Image size 1924x1556. Ultra-widefield fundus mosaic — 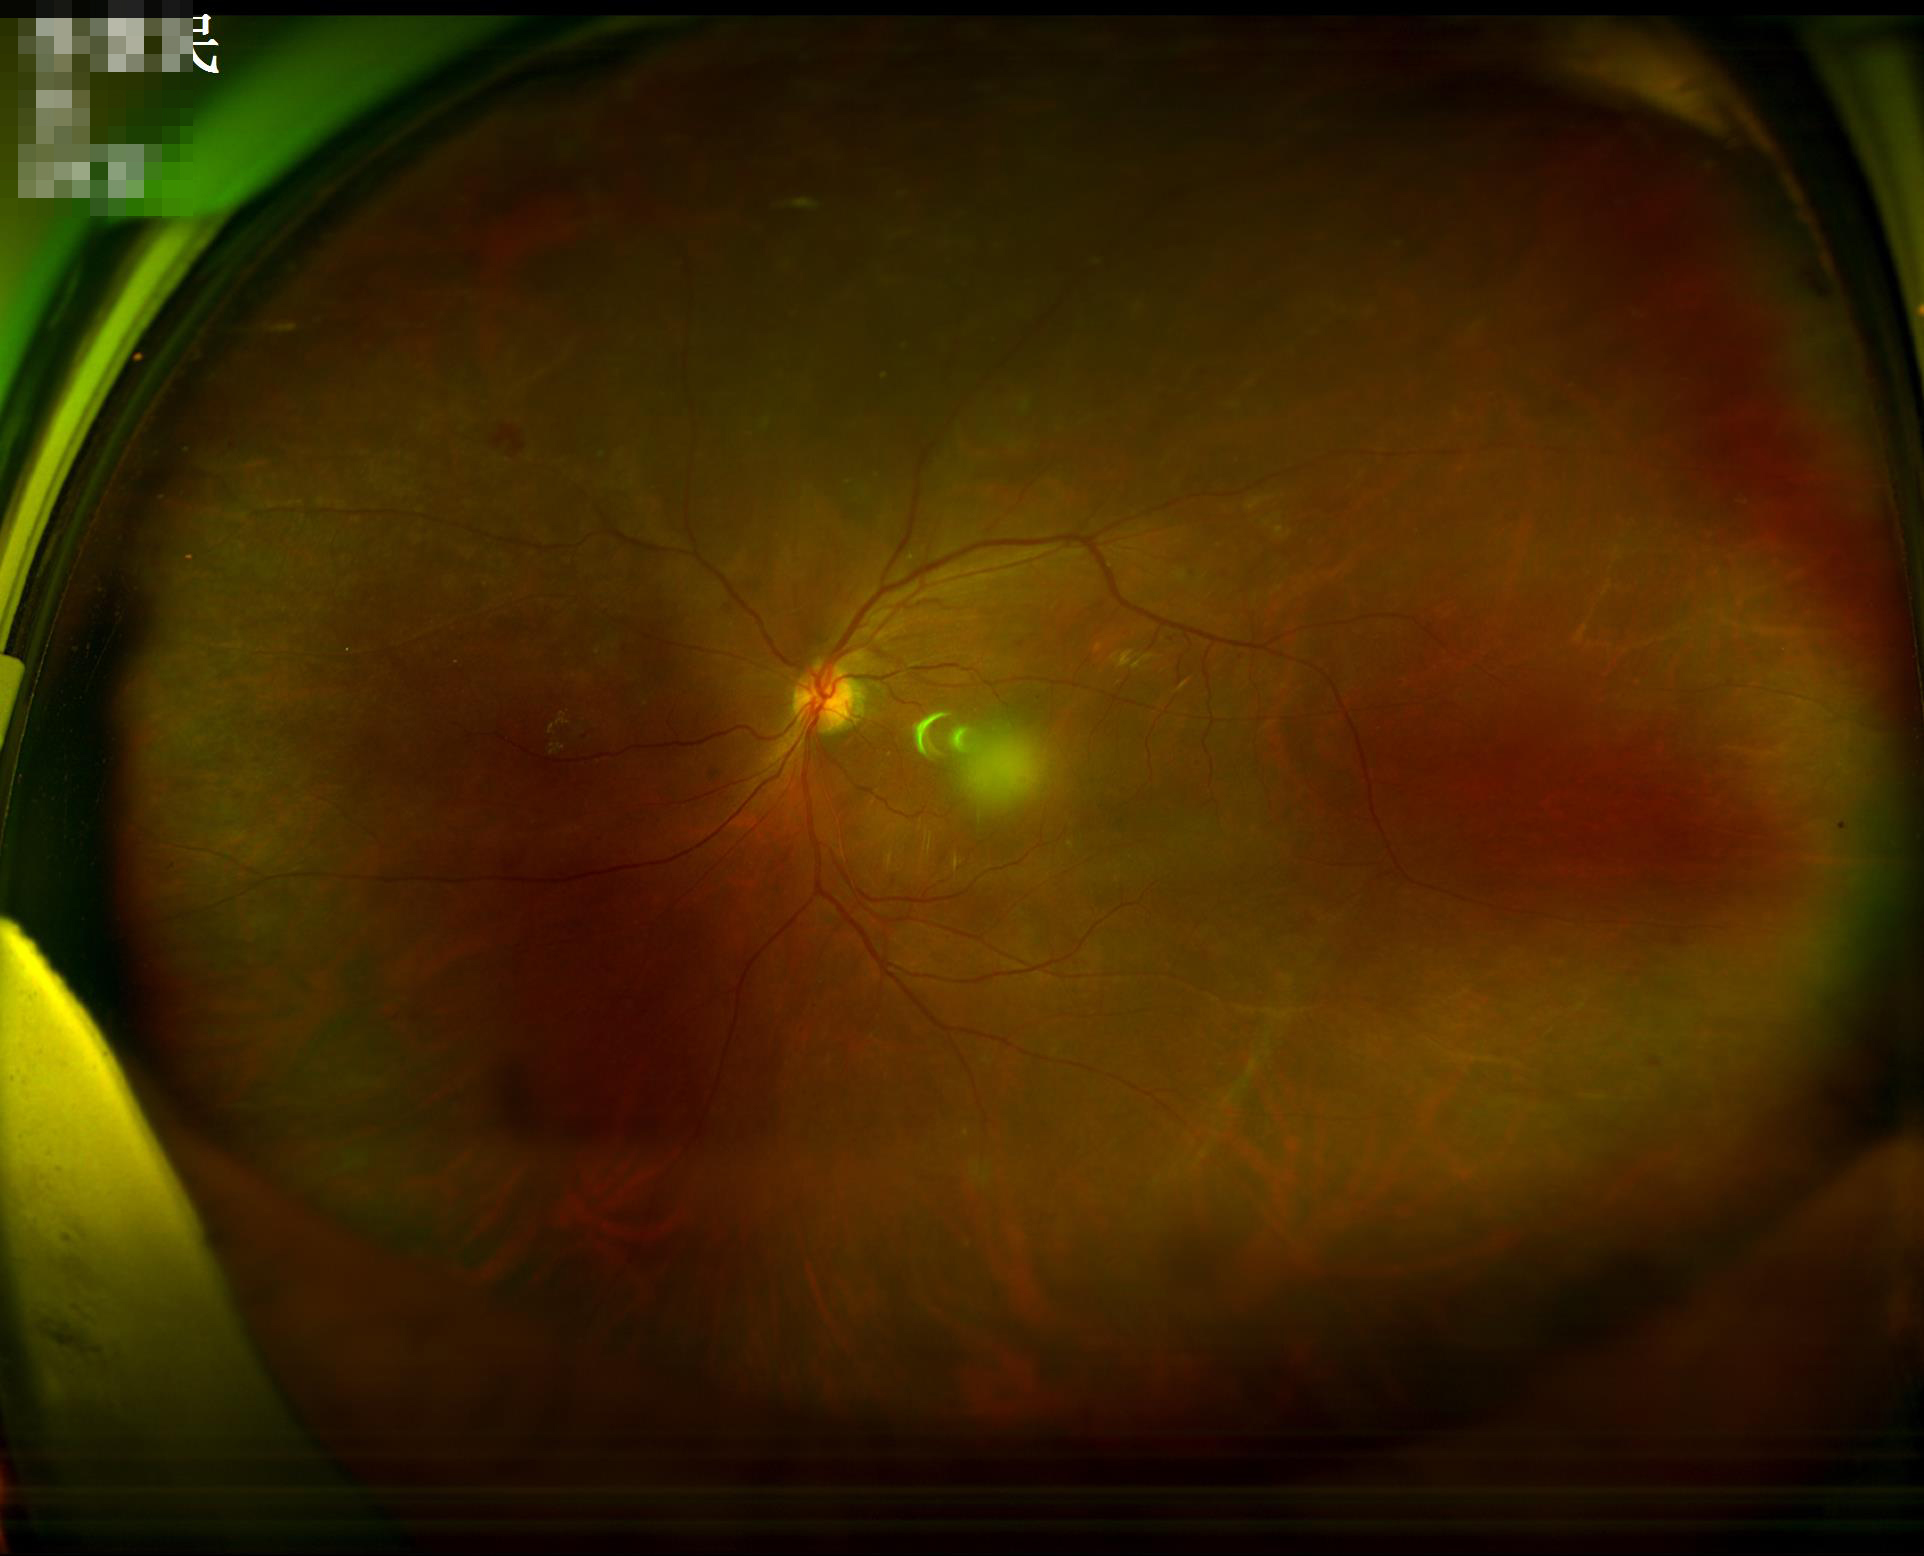

overall_quality: acceptable
illumination: adequate
clarity: blurry